Ultra-widefield fundus photograph
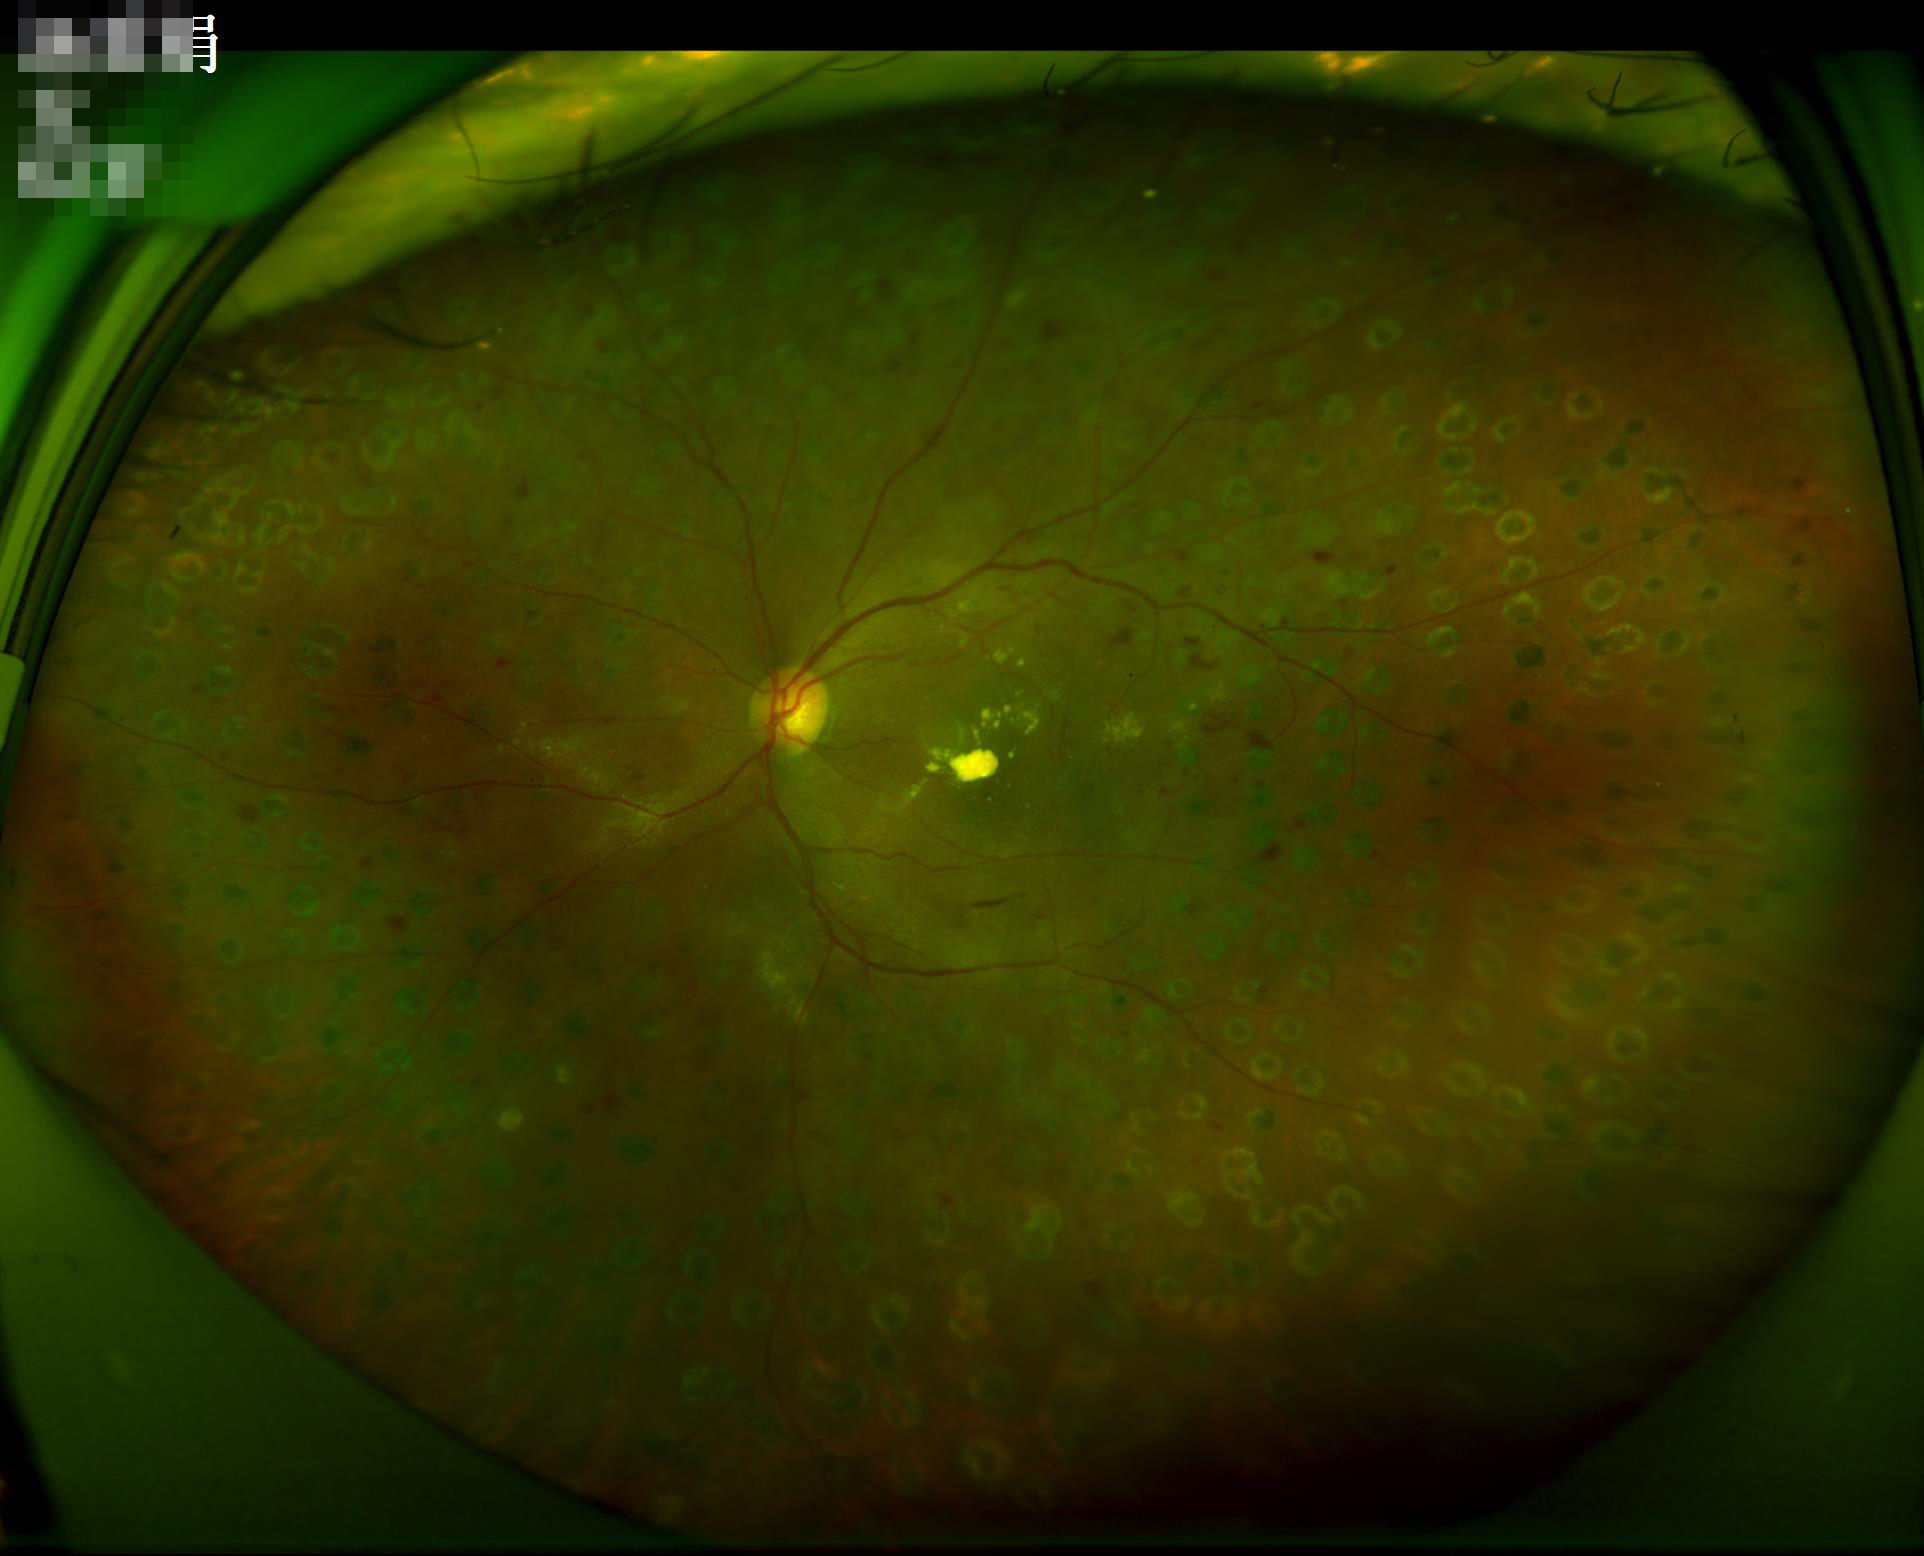 Image quality:
- sharpness: clear with no noticeable blur
- overall: good and suitable for diagnostic use
- contrast: good dynamic range